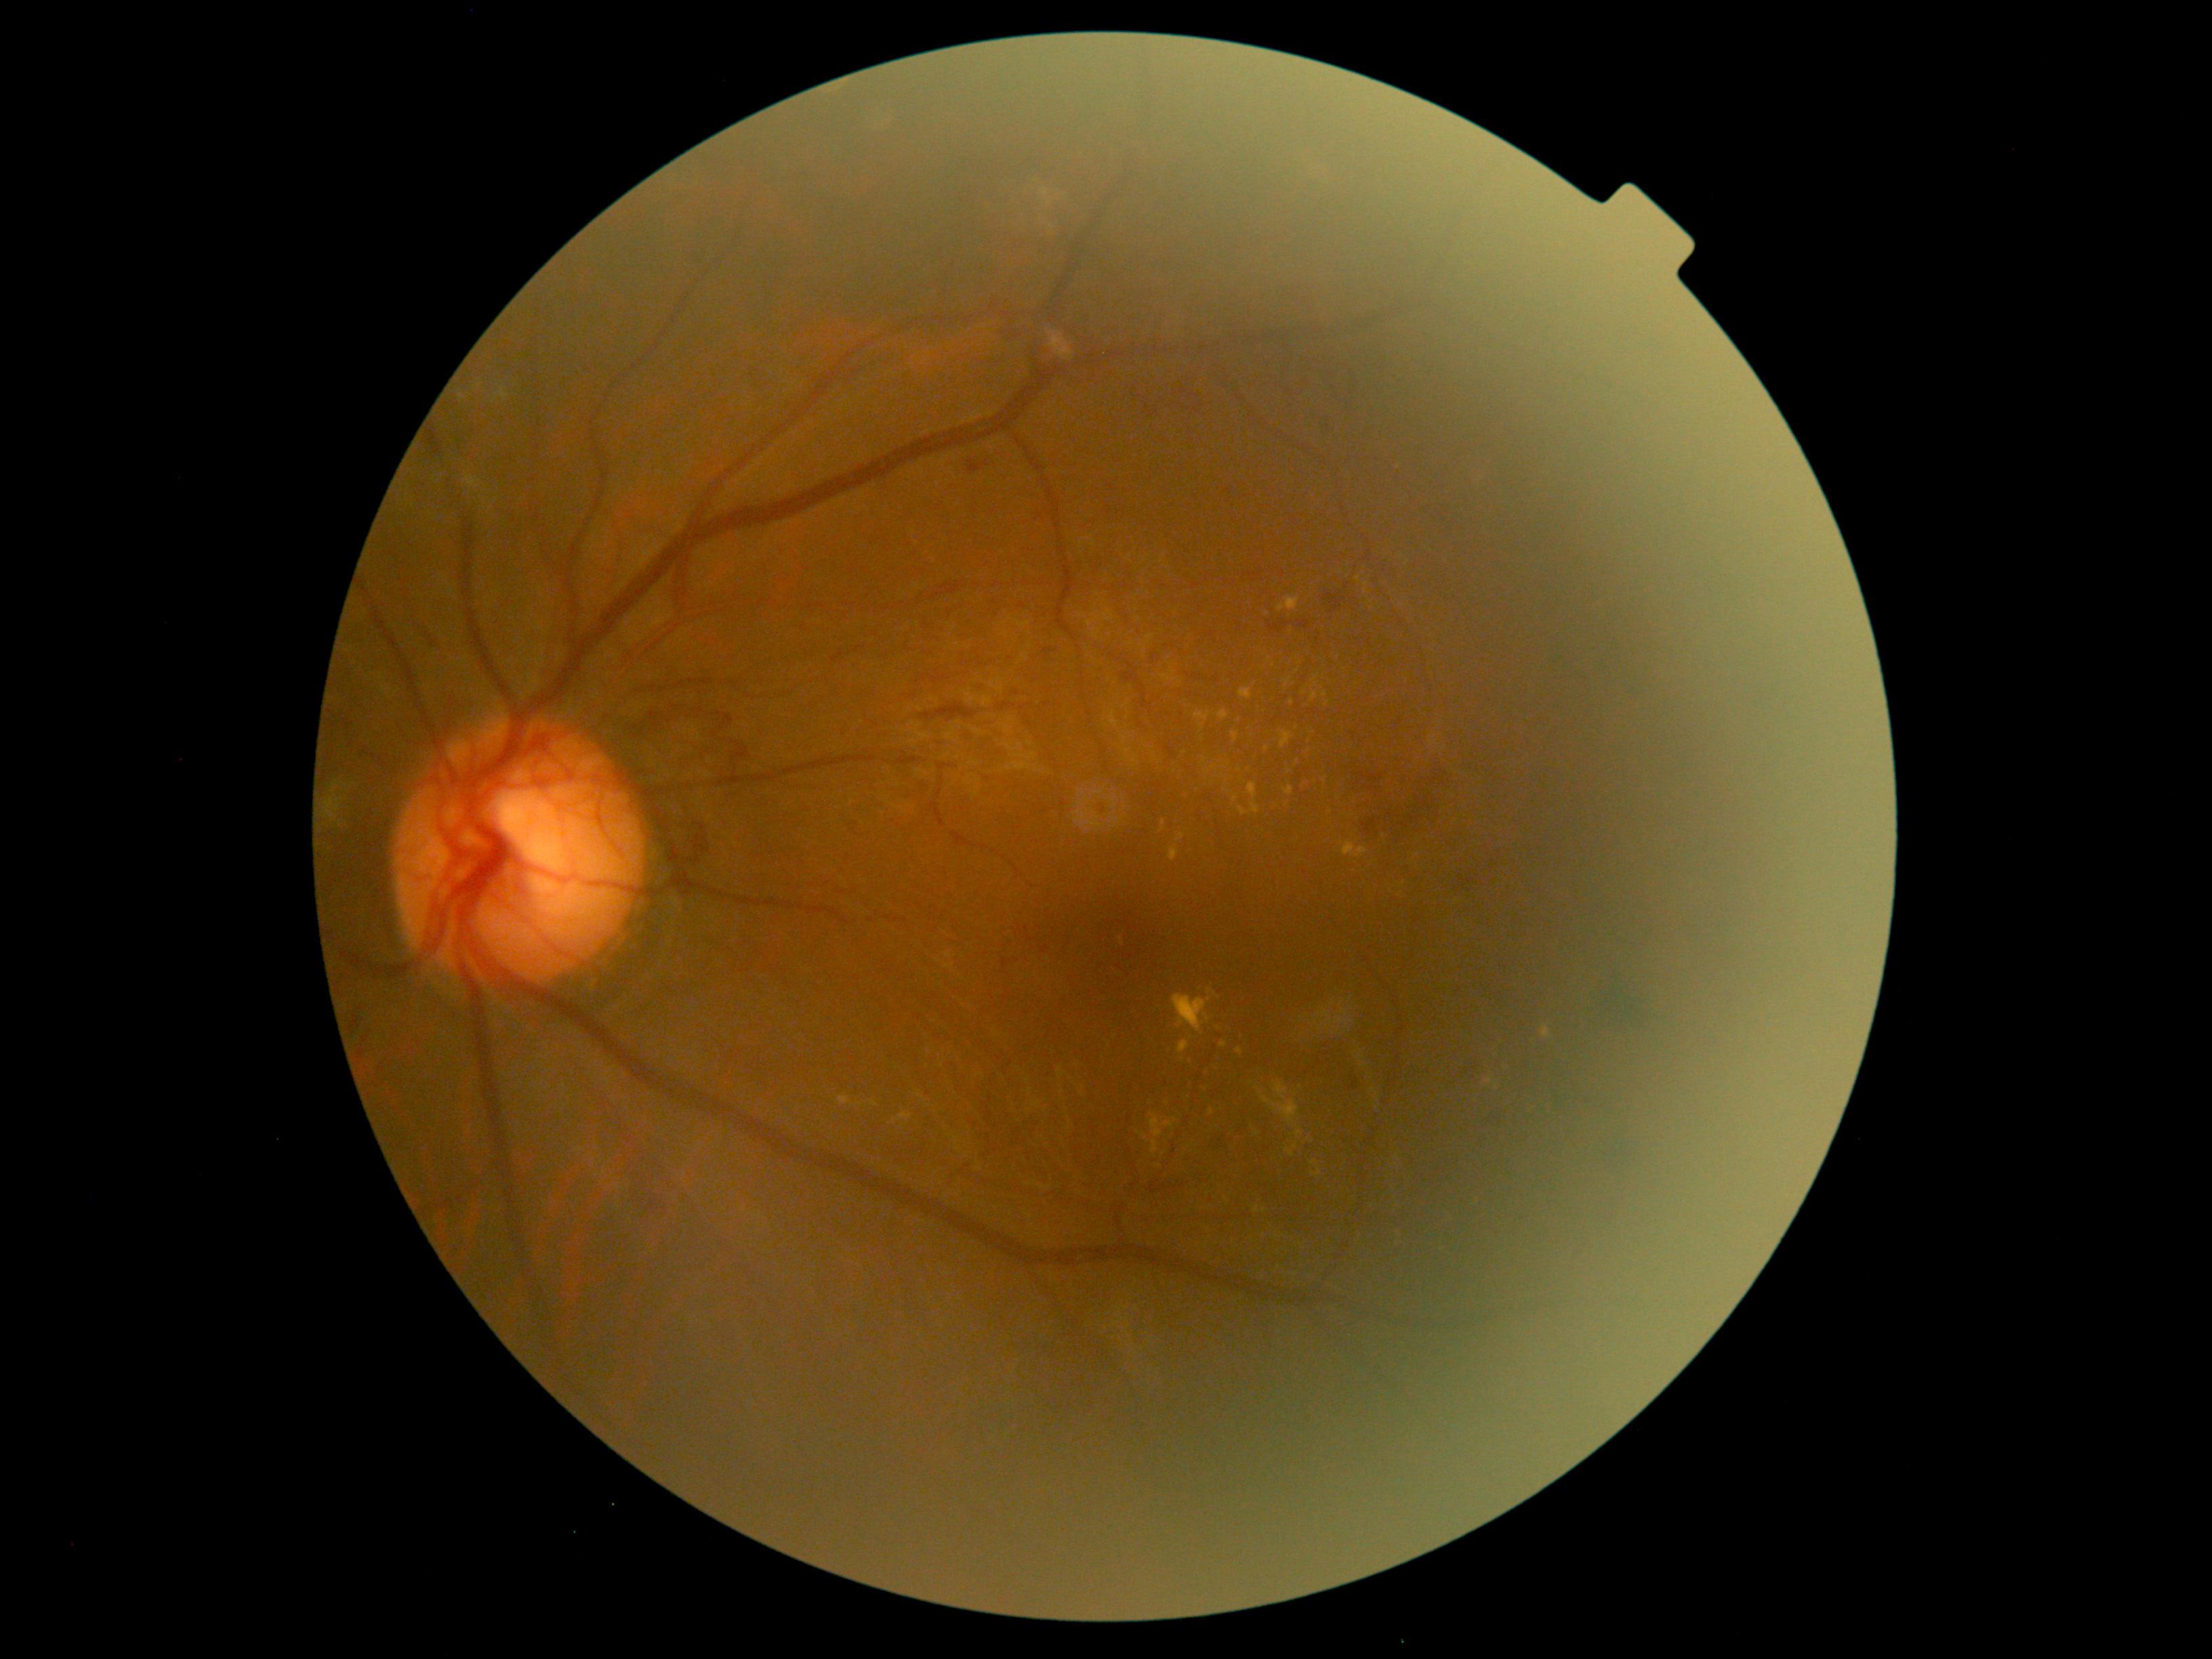

DR grade is proliferative diabetic retinopathy (4).